Camera: Natus RetCam Envision (130° FOV). Wide-field fundus image from infant ROP screening: 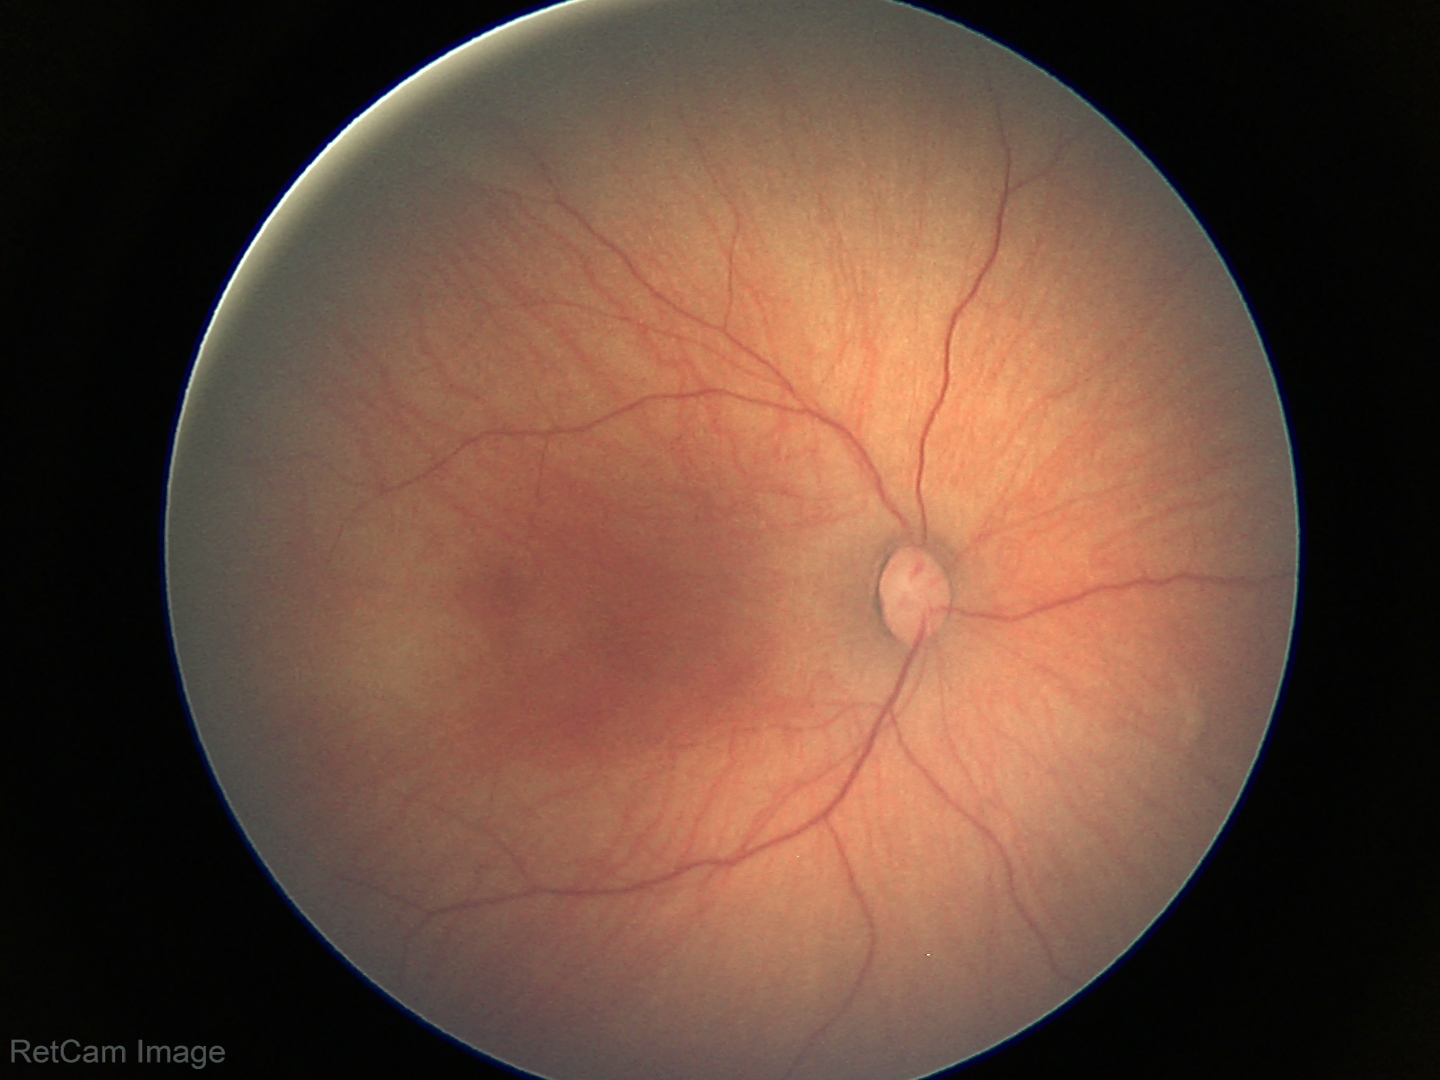 Screening examination with no abnormal retinal findings.